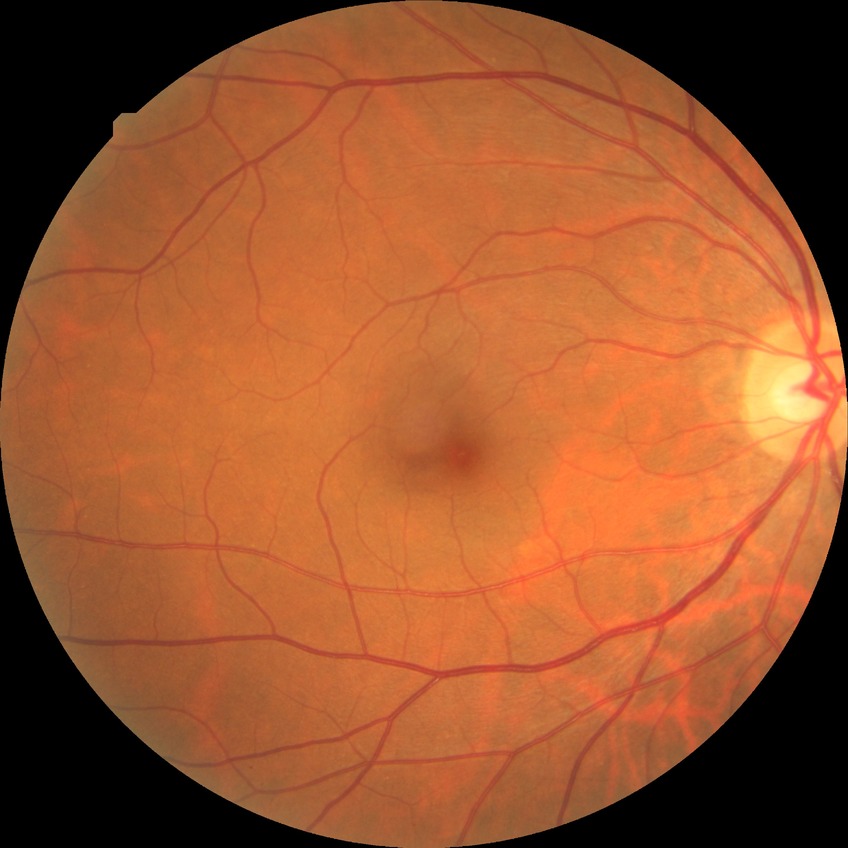
DR grade: NDR.